100° field of view (Phoenix ICON) · wide-field contact fundus photograph of an infant: 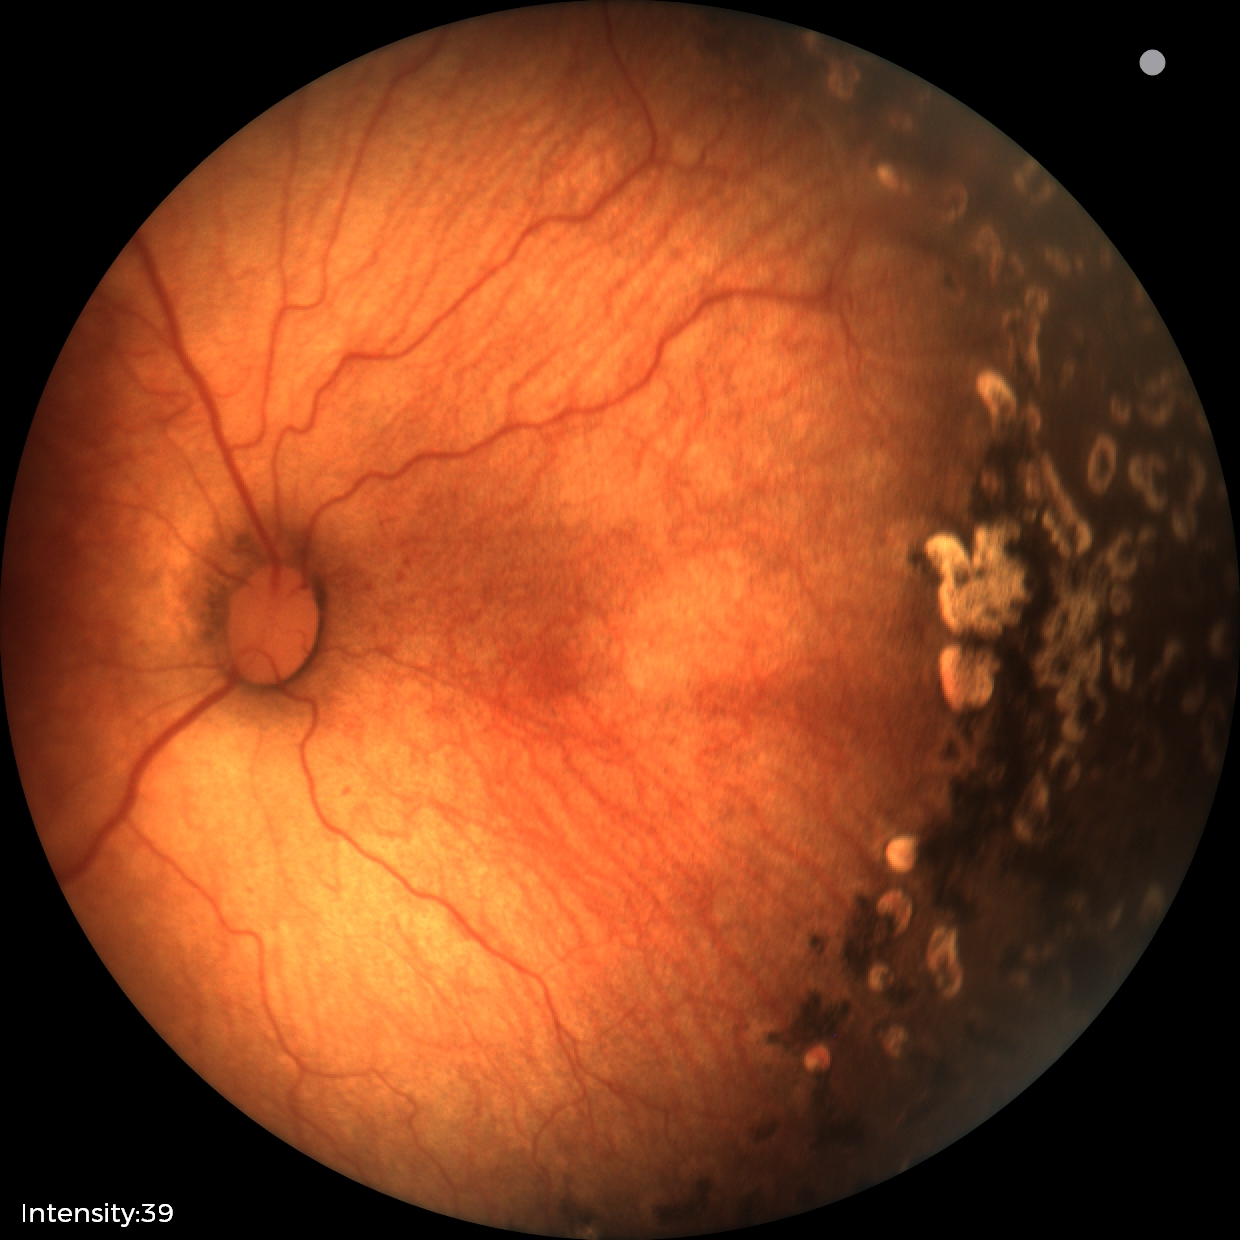

Q: Plus disease status?
A: no plus disease — posterior pole vessels without abnormal dilation or tortuosity
Q: What is the screening diagnosis?
A: status post retinopathy of prematurity